Wide-field fundus photograph from neonatal ROP screening: 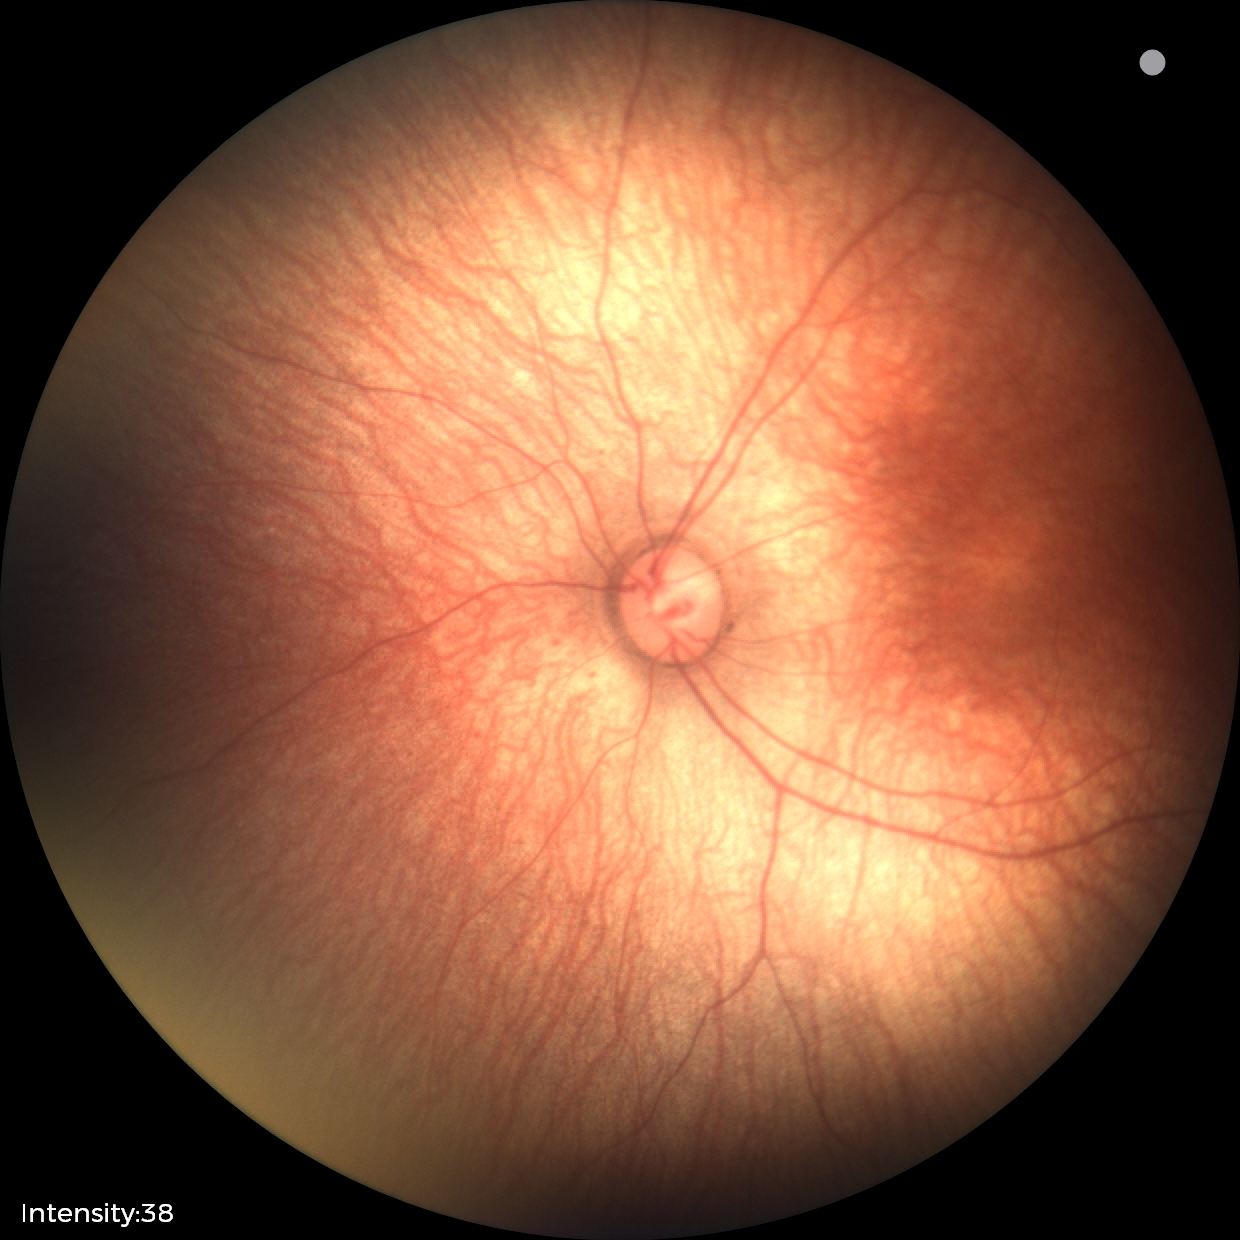 Physiological retinal appearance for postconceptual age.